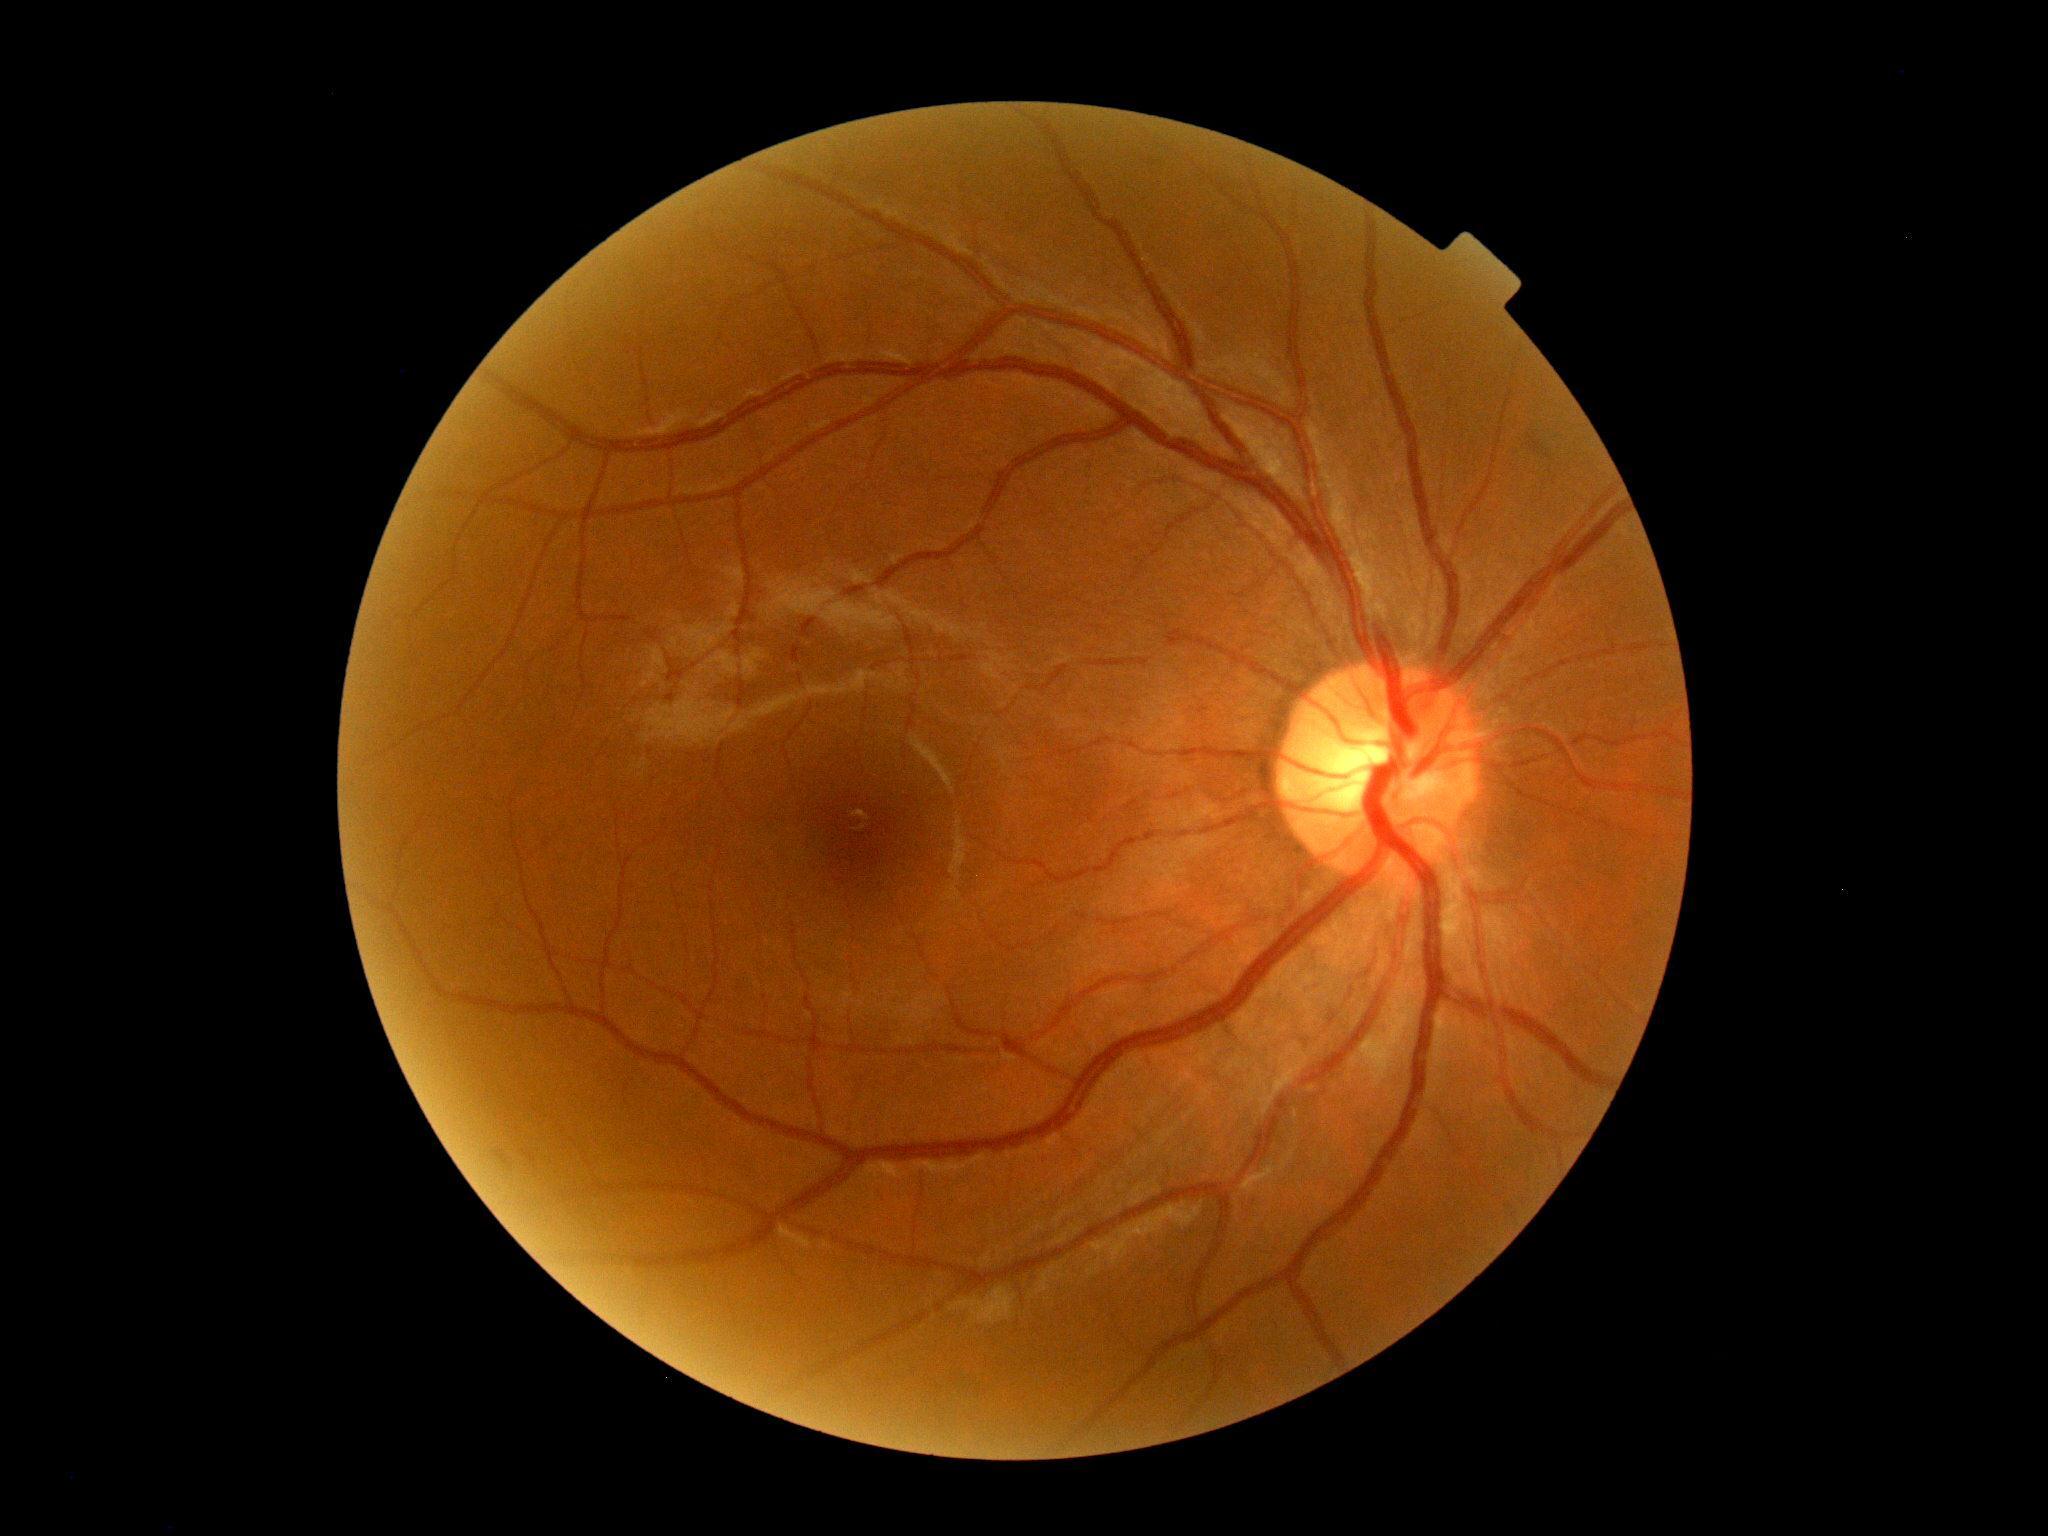
dr_grade: 0/4
dr_impression: no signs of DR